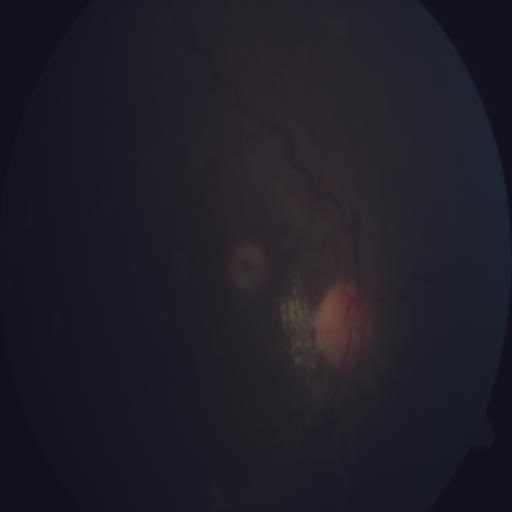
Fundus image with findings of MH (media haze).